Topcon TRC-50DX — 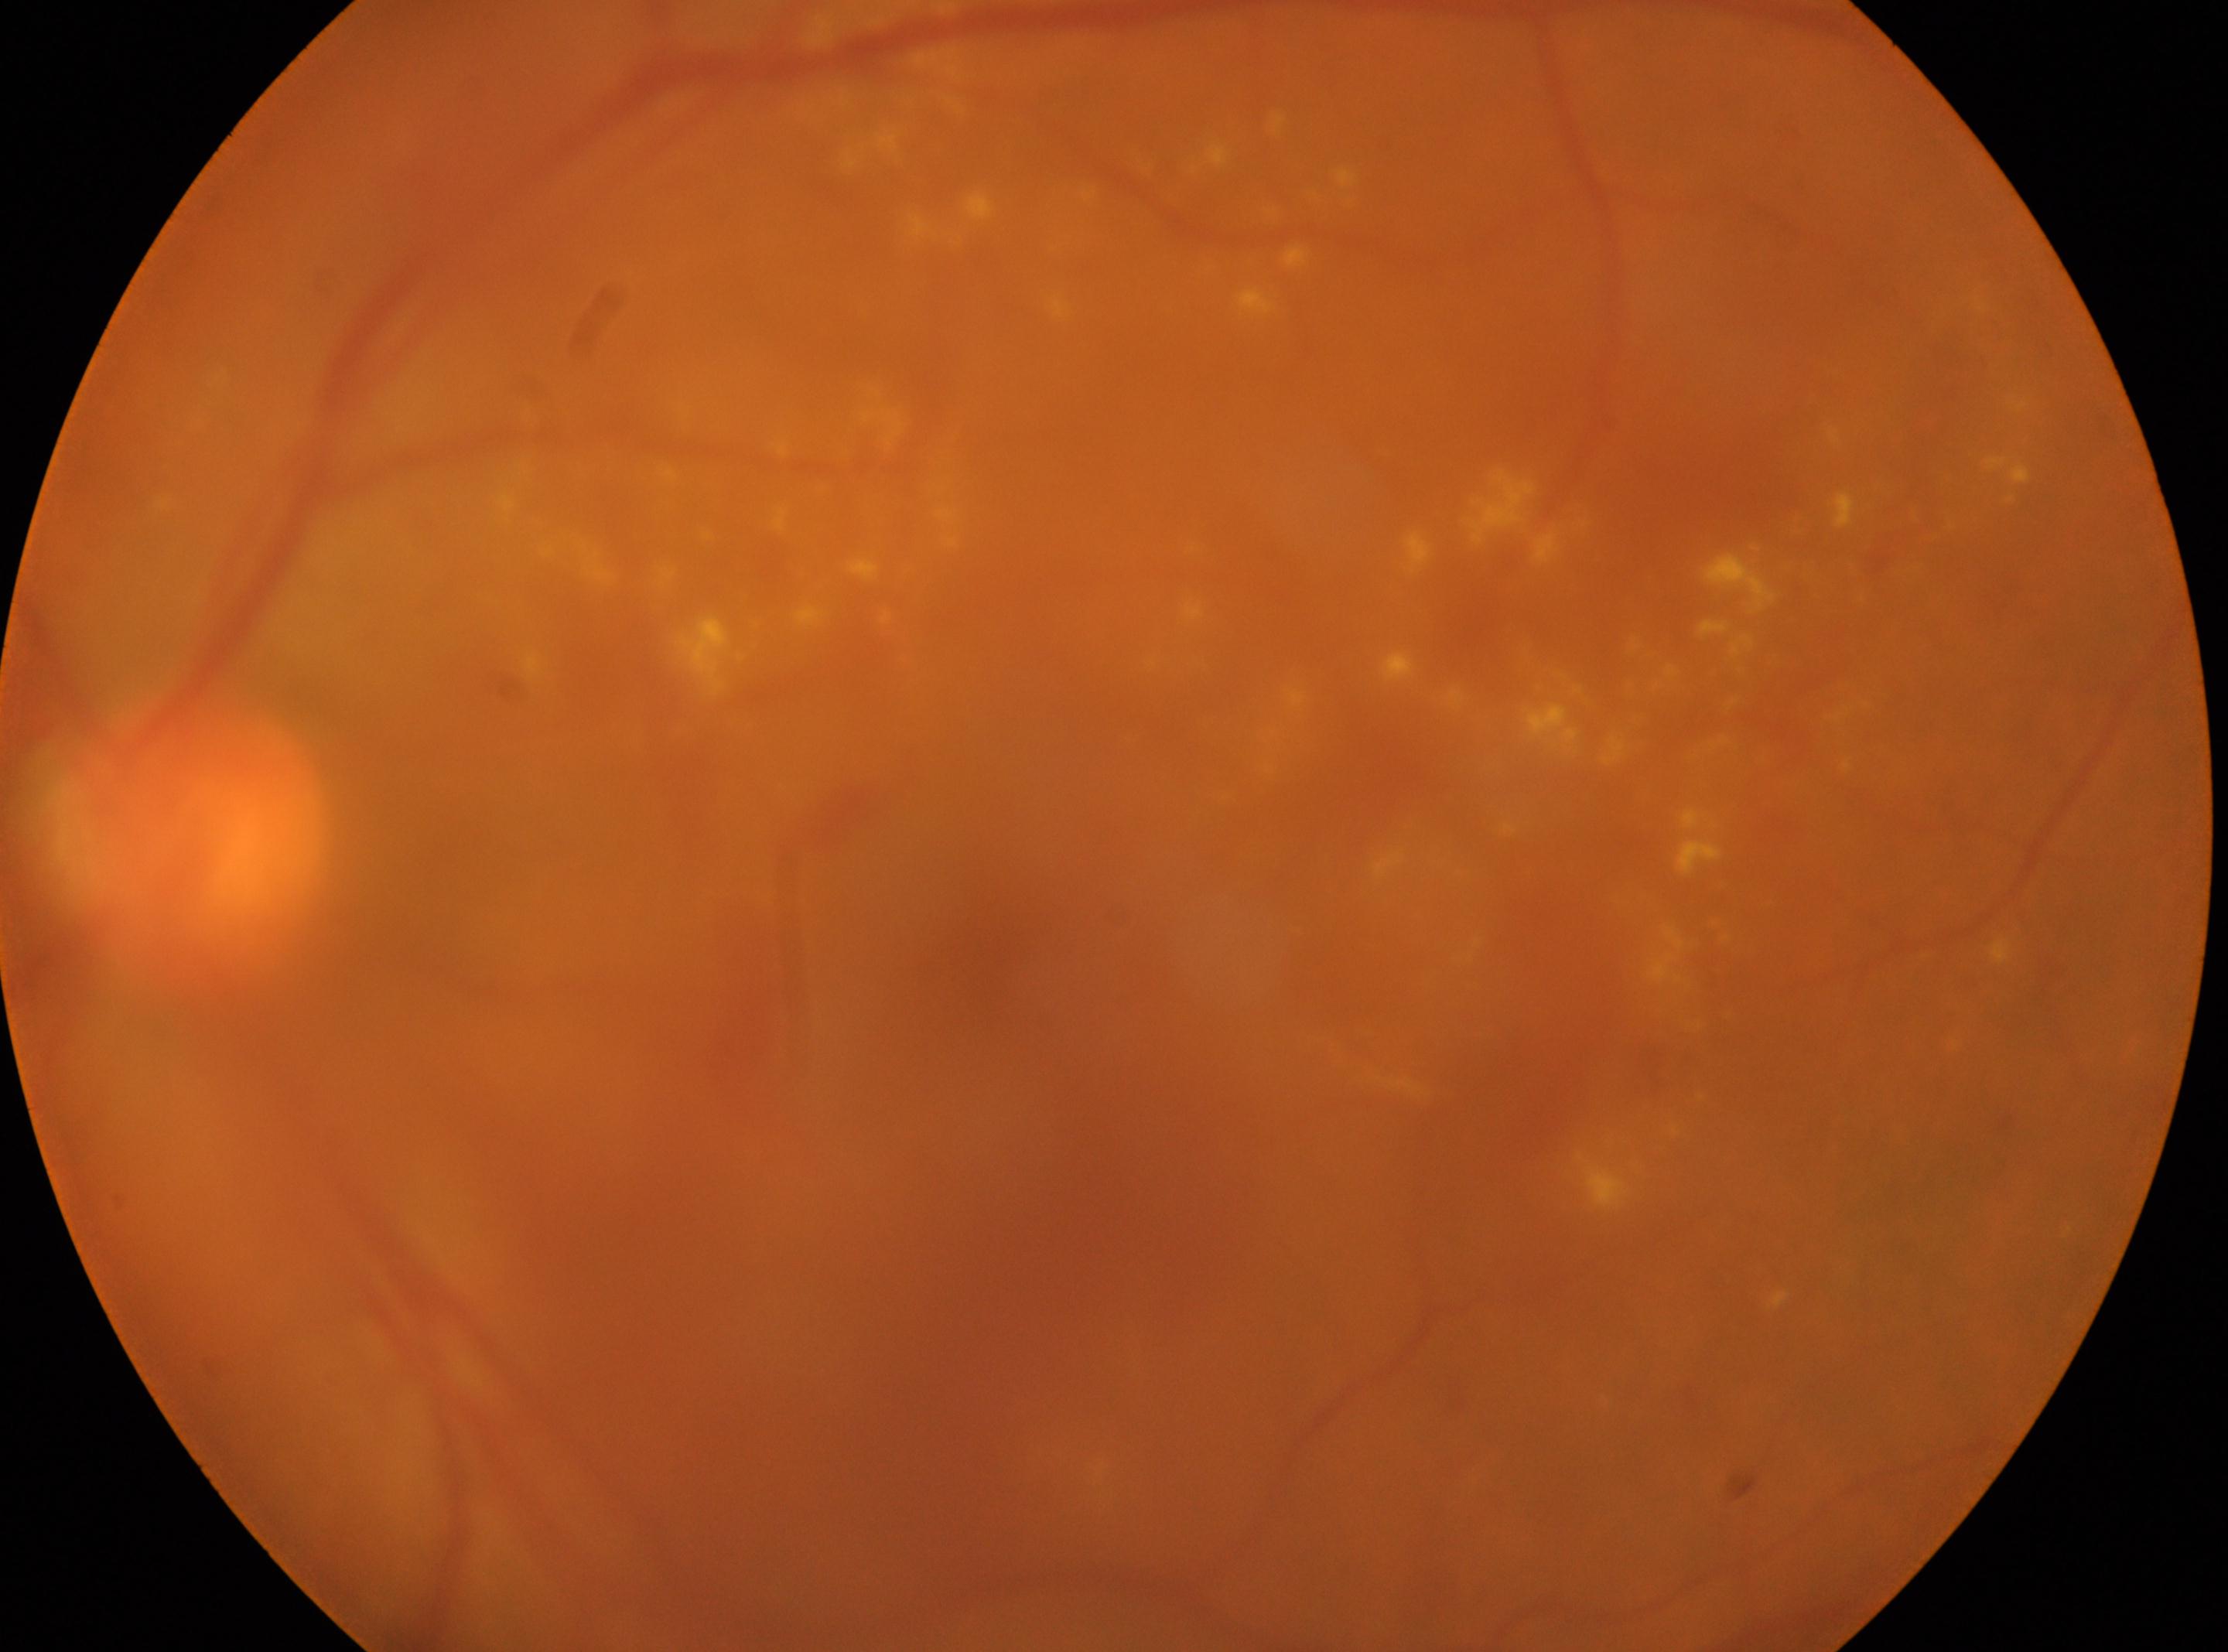
Optic disk: (x=187, y=841).
Imaged eye: the left eye.
Macular center: (x=987, y=965).
Retinopathy: grade 2.